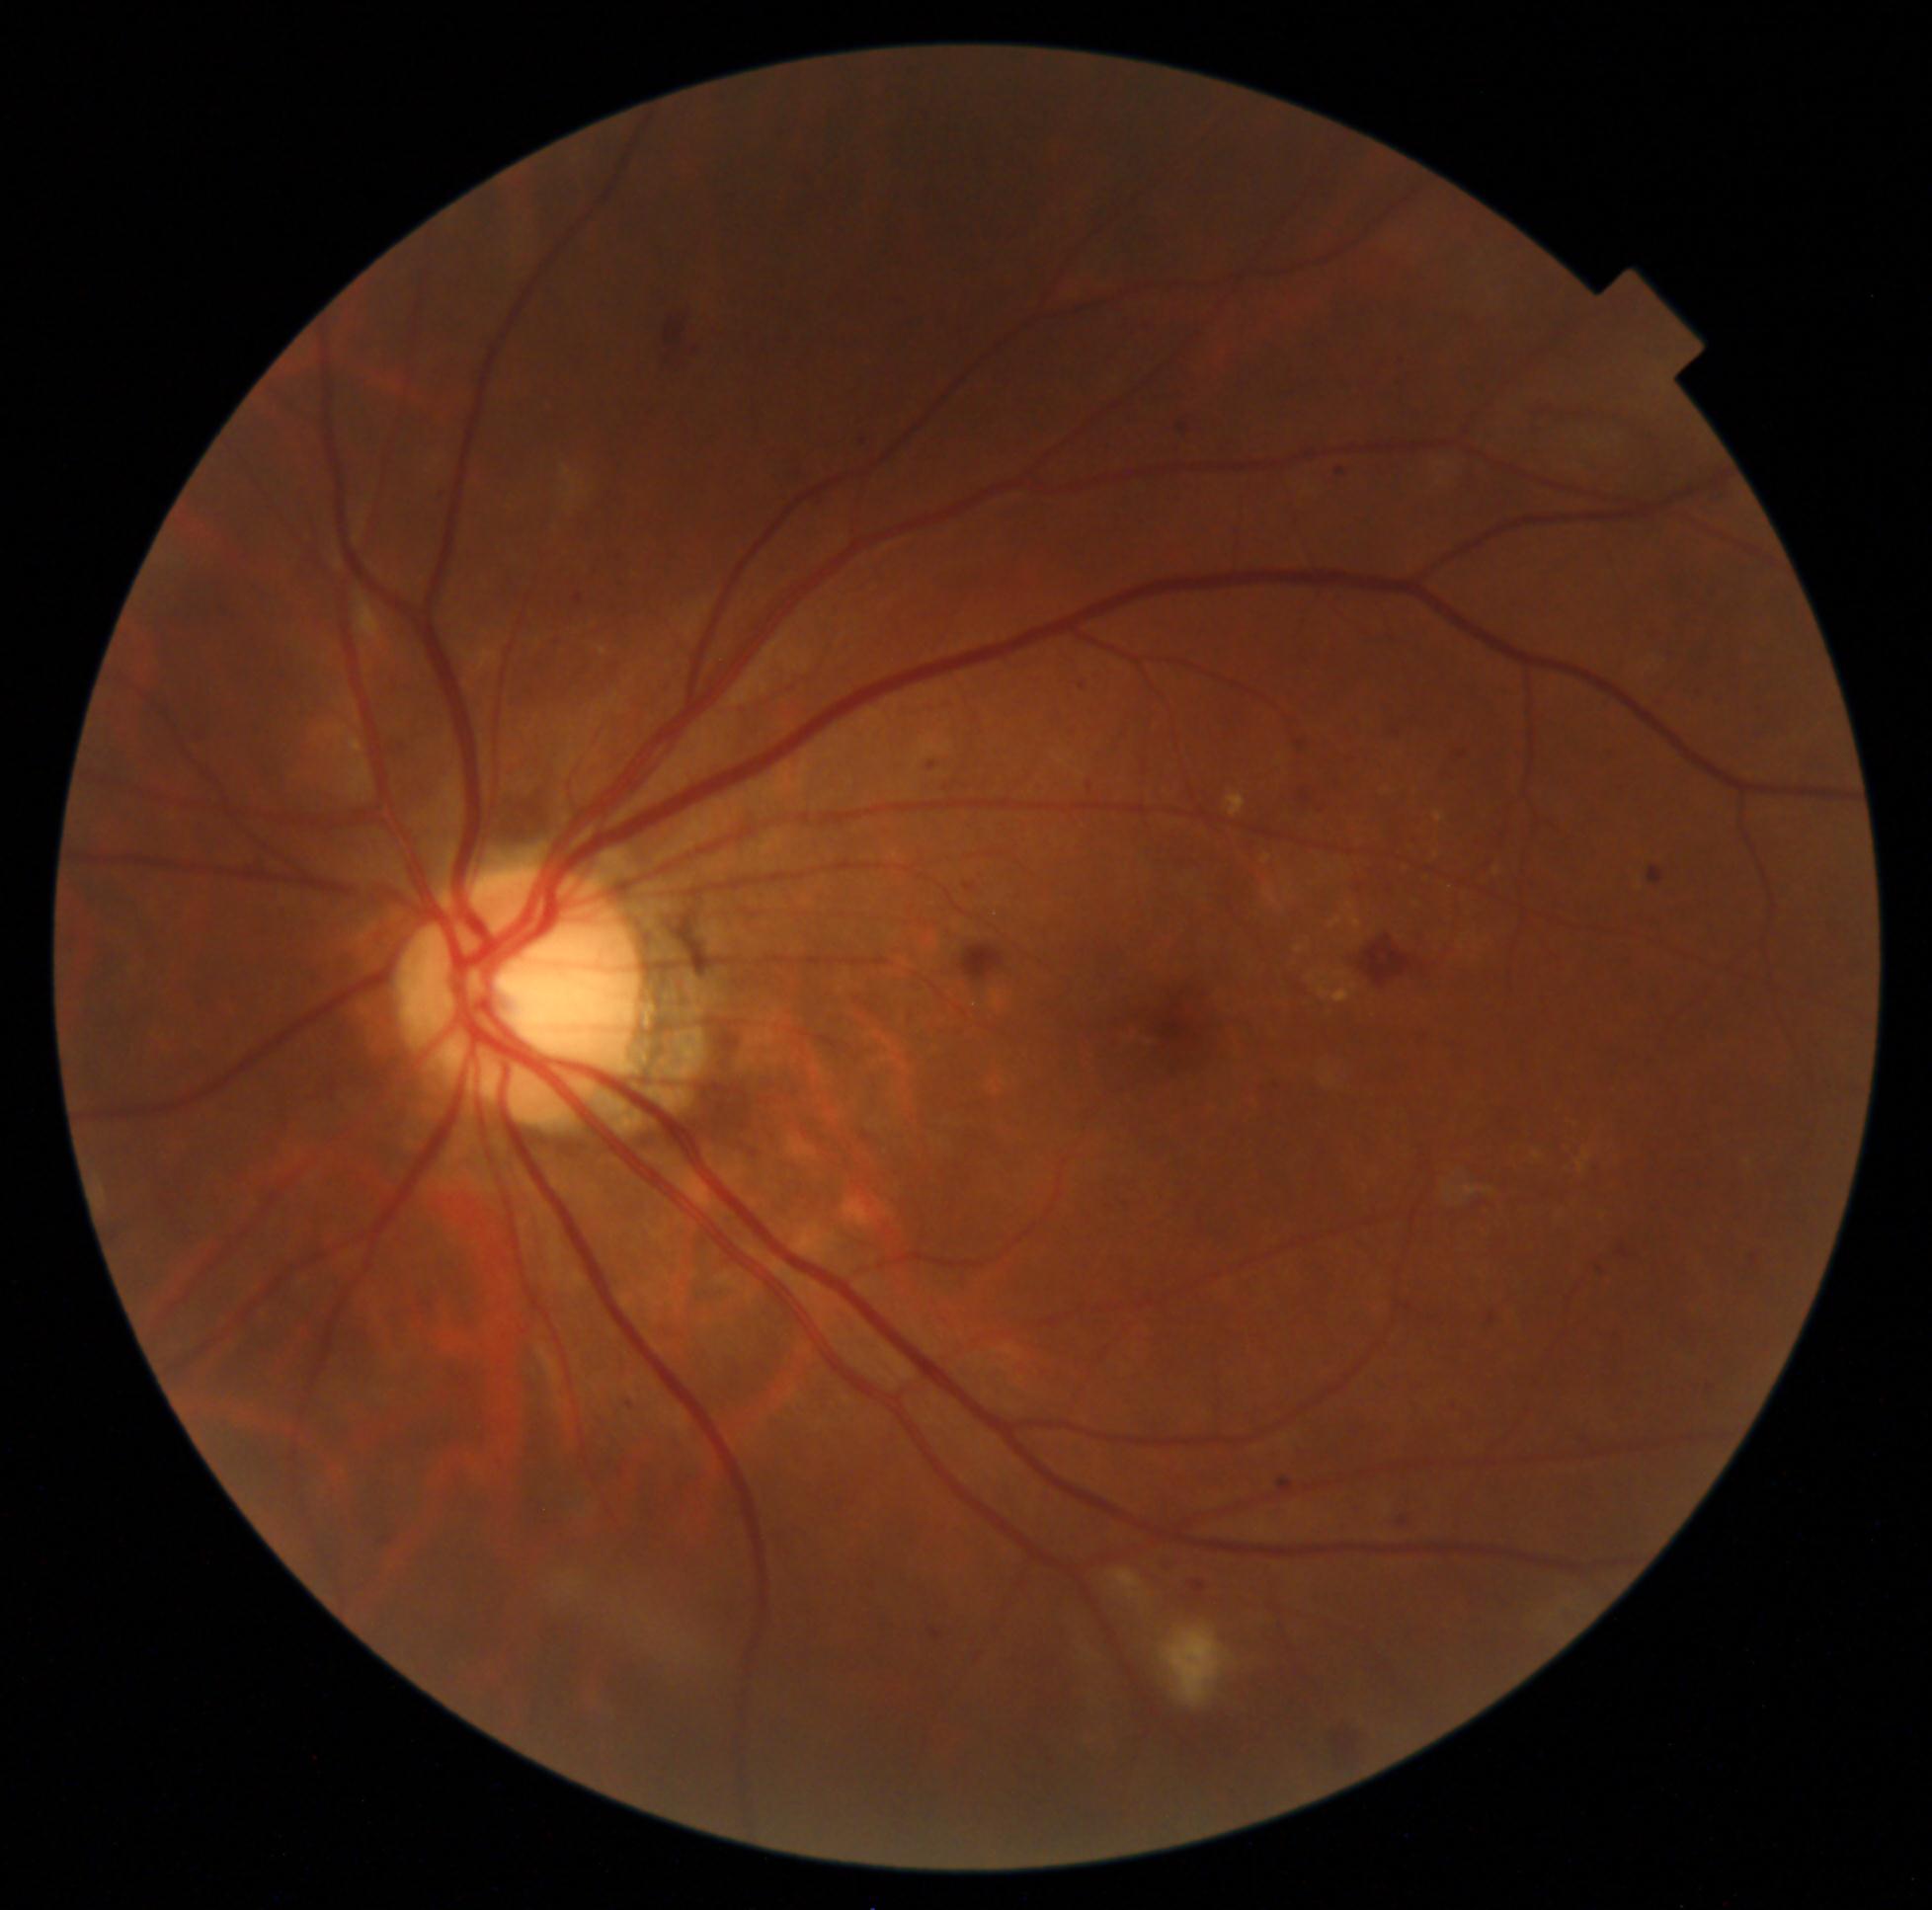
Diabetic retinopathy (DR): grade 2 — more than just microaneurysms but less than severe NPDR.